Graded on the modified Davis scale
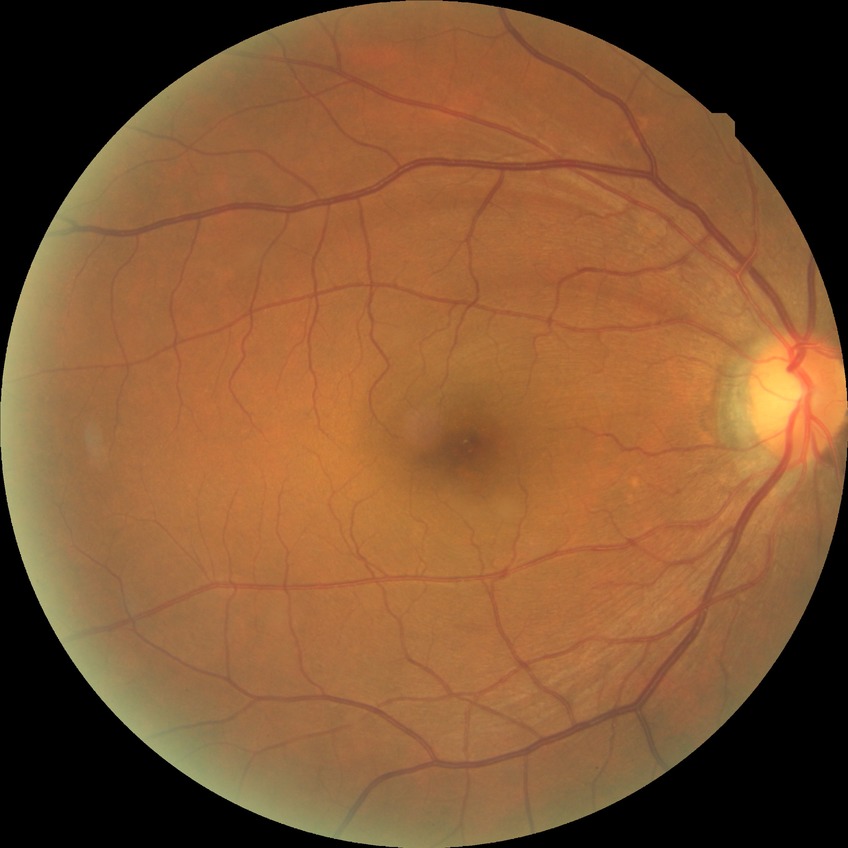
Assessment:
- diabetic retinopathy (DR) — no diabetic retinopathy (NDR)